FOV: 45 degrees · retinal fundus photograph
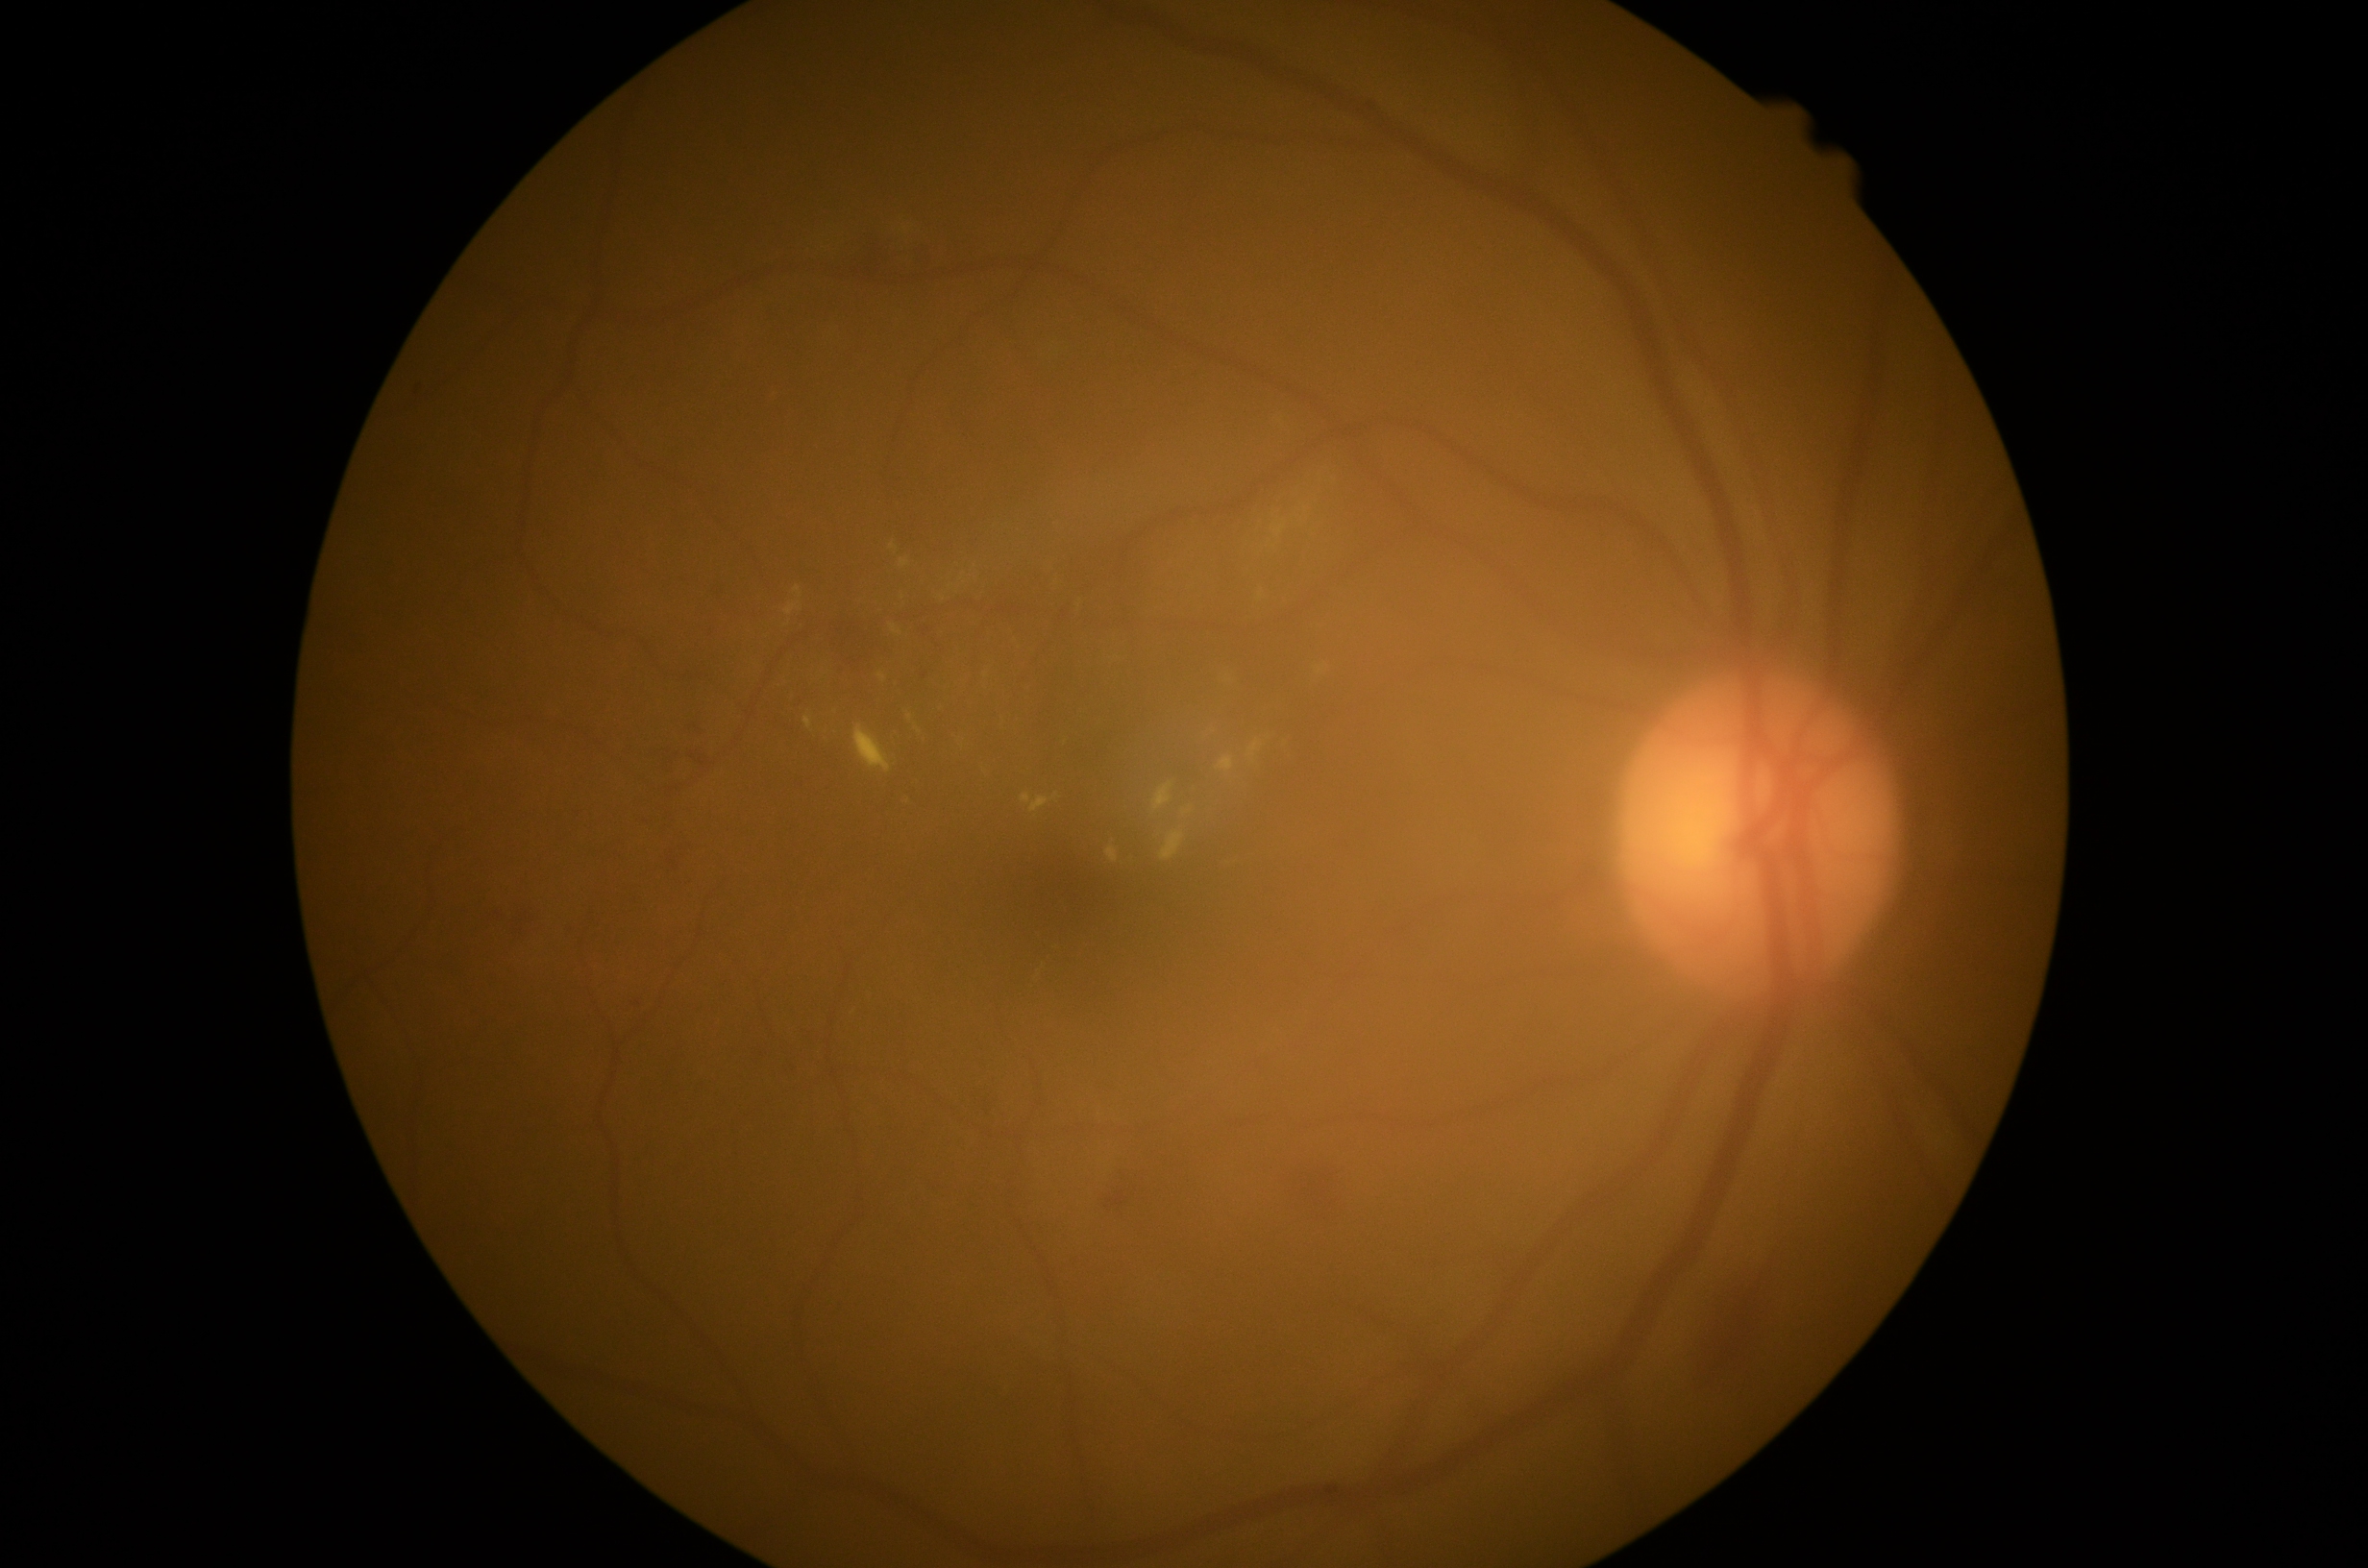
dr_grade: grade 2